45° field of view. 848x848px. NIDEK AFC-230.
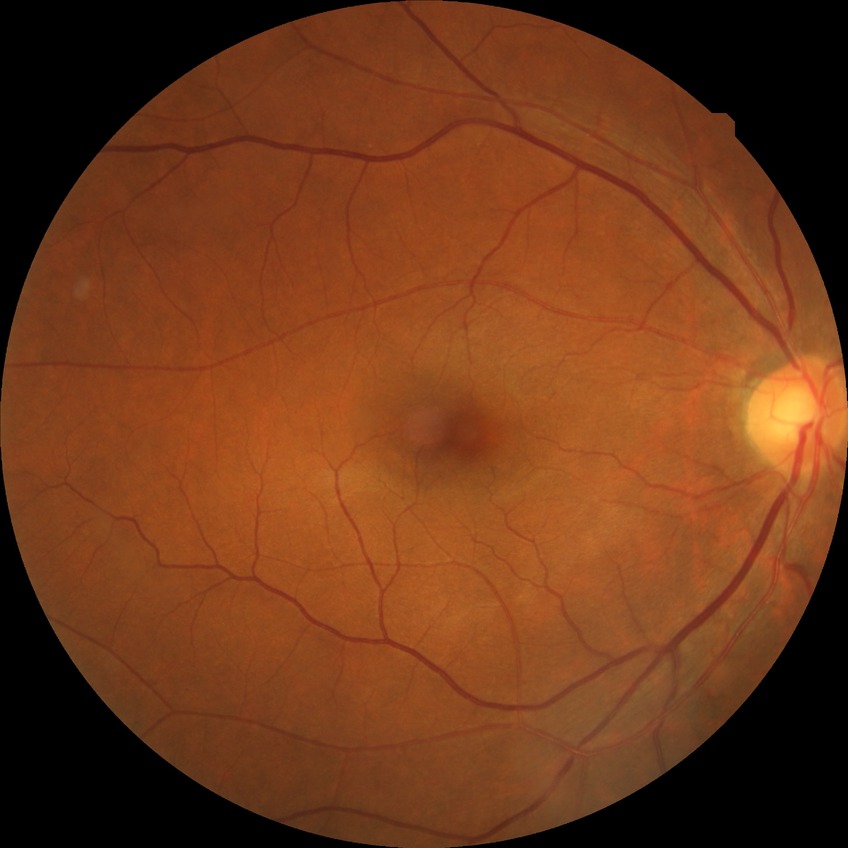

Davis DR grade = NDR.